Wide-field fundus photograph from neonatal ROP screening — 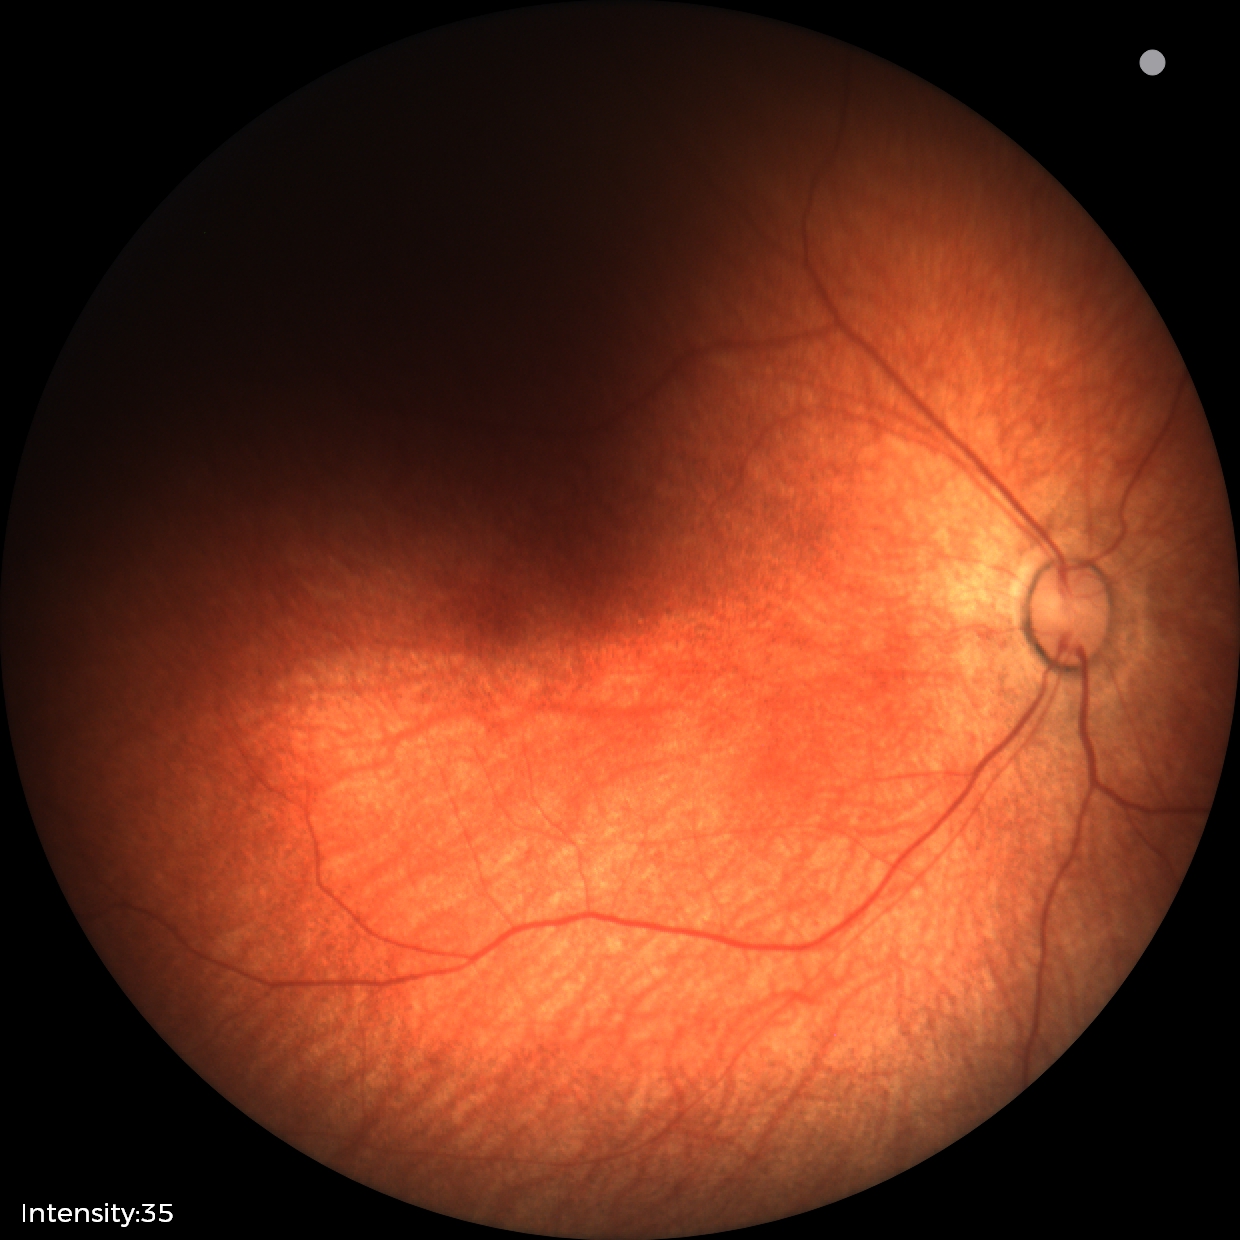

Finding: physiological appearance.